Infant wide-field retinal image
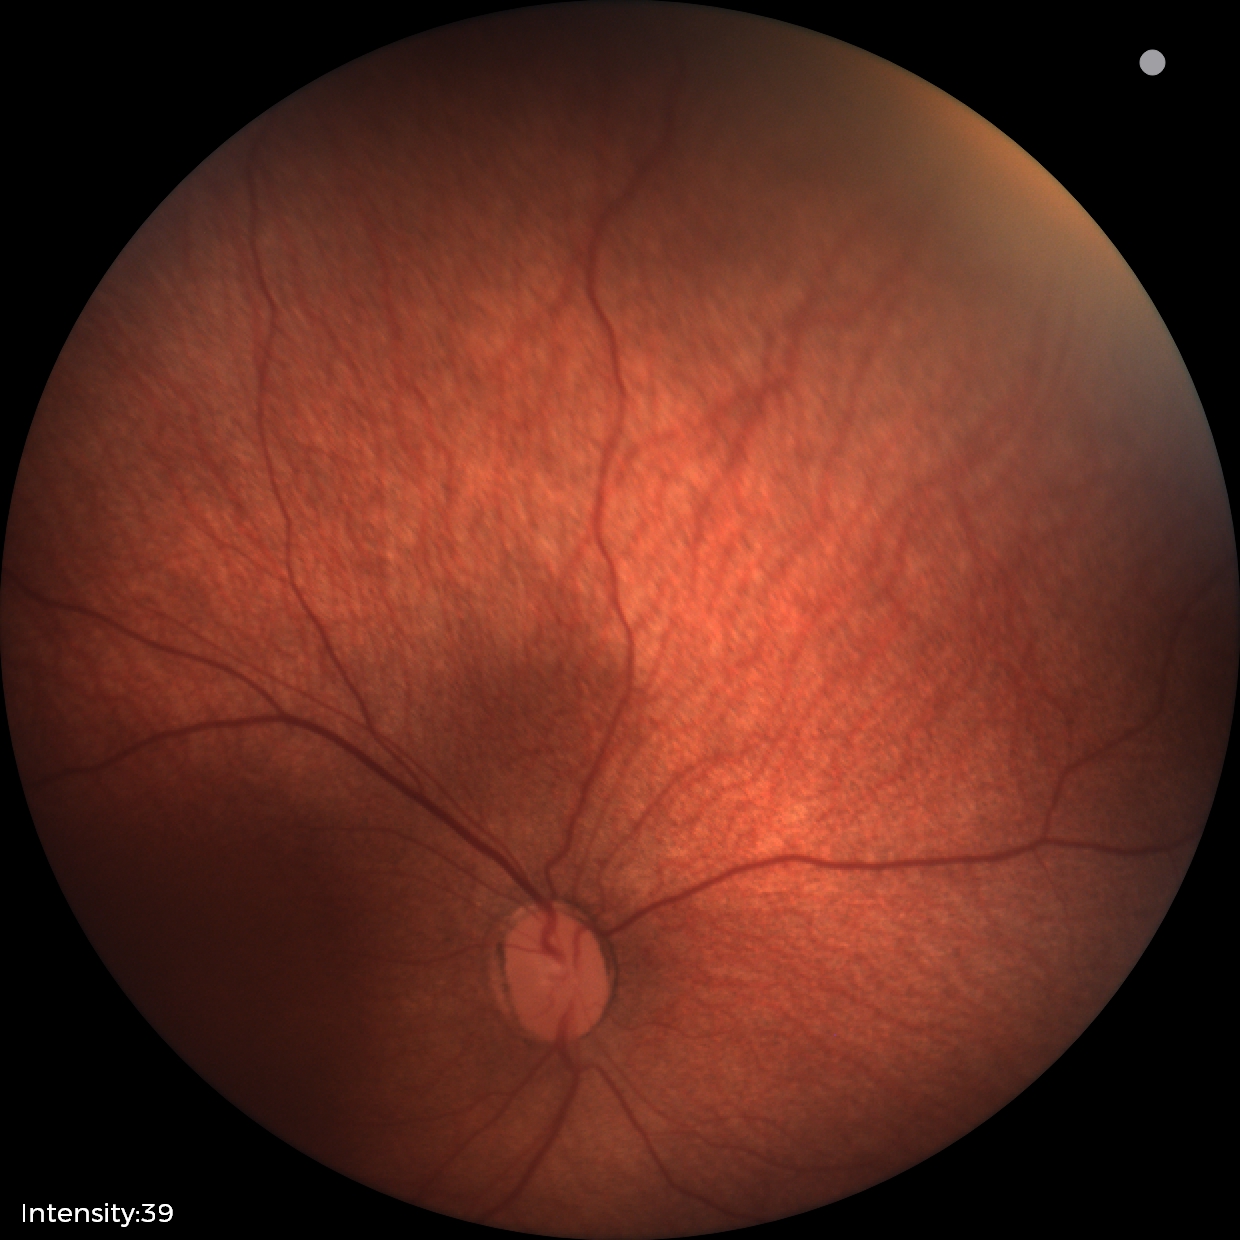 No plus disease. Series diagnosed as status post retinopathy of prematurity.